Wide-field fundus photograph of an infant; acquired on the Phoenix ICON:
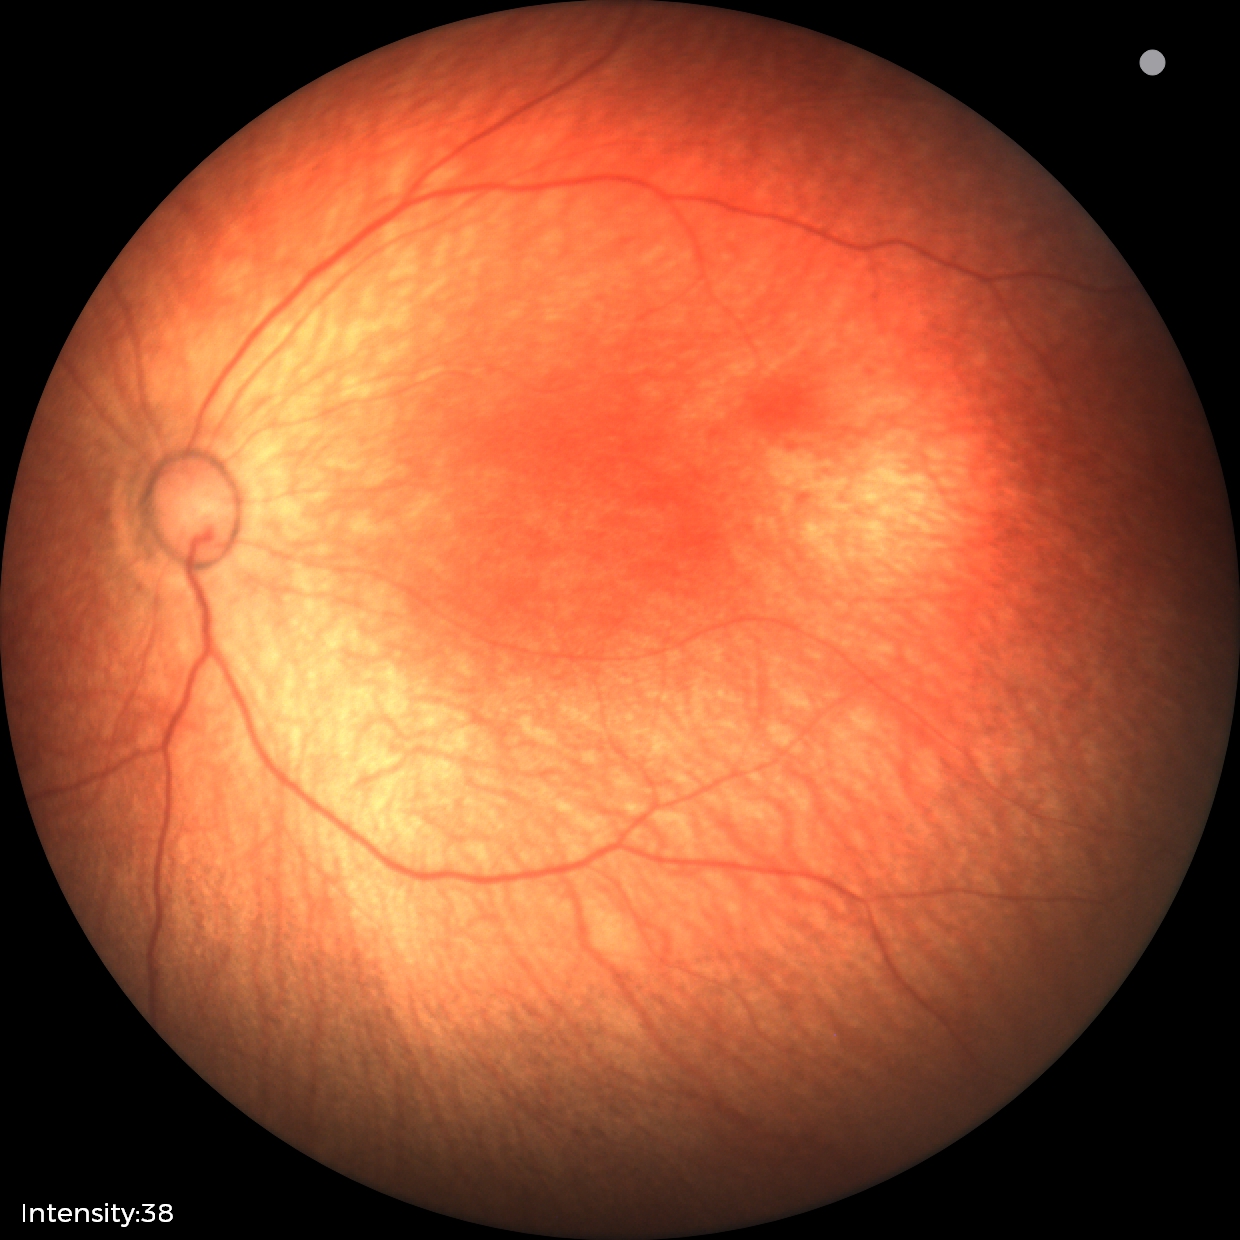
Screening examination diagnosed as physiological.